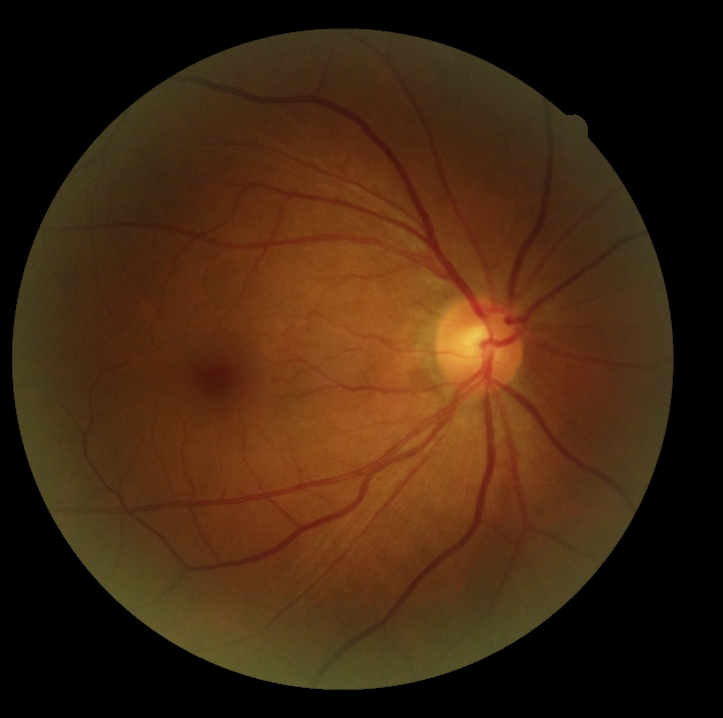
dr_grade: no apparent retinopathy (grade 0)